45-degree field of view. NIDEK AFC-230 fundus camera. Without pupil dilation:
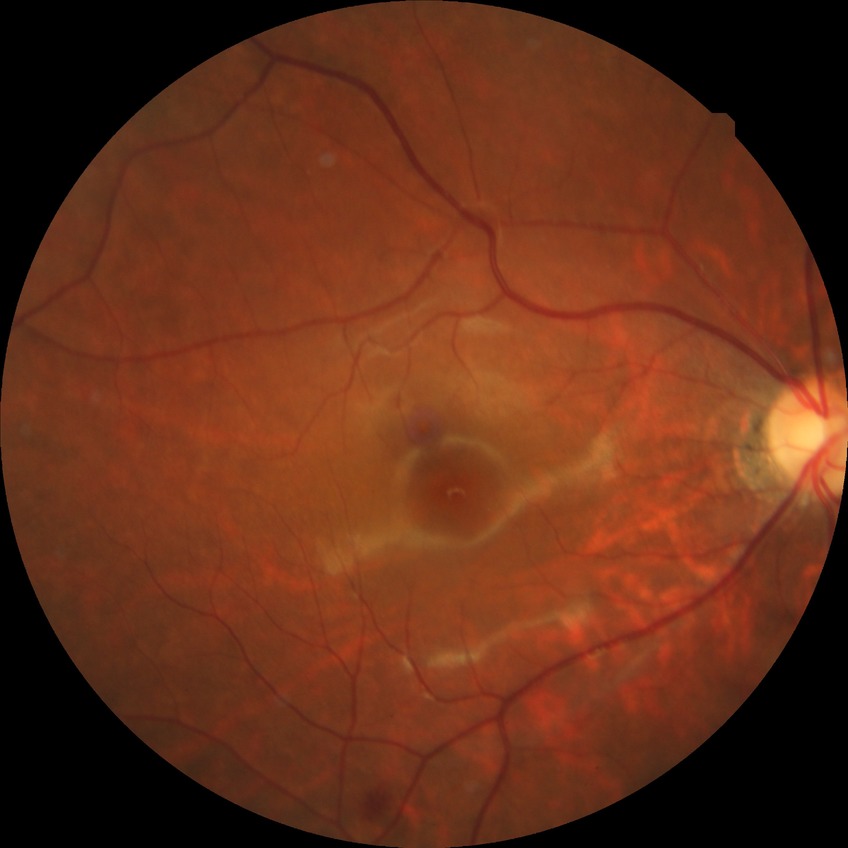 diabetic retinopathy (DR) = SDR (simple diabetic retinopathy)